Cropped to the optic nerve head
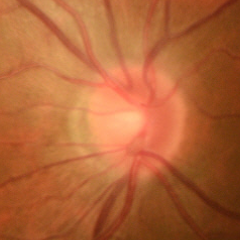 Color fundus photograph showing no glaucomatous findings.